CFP:
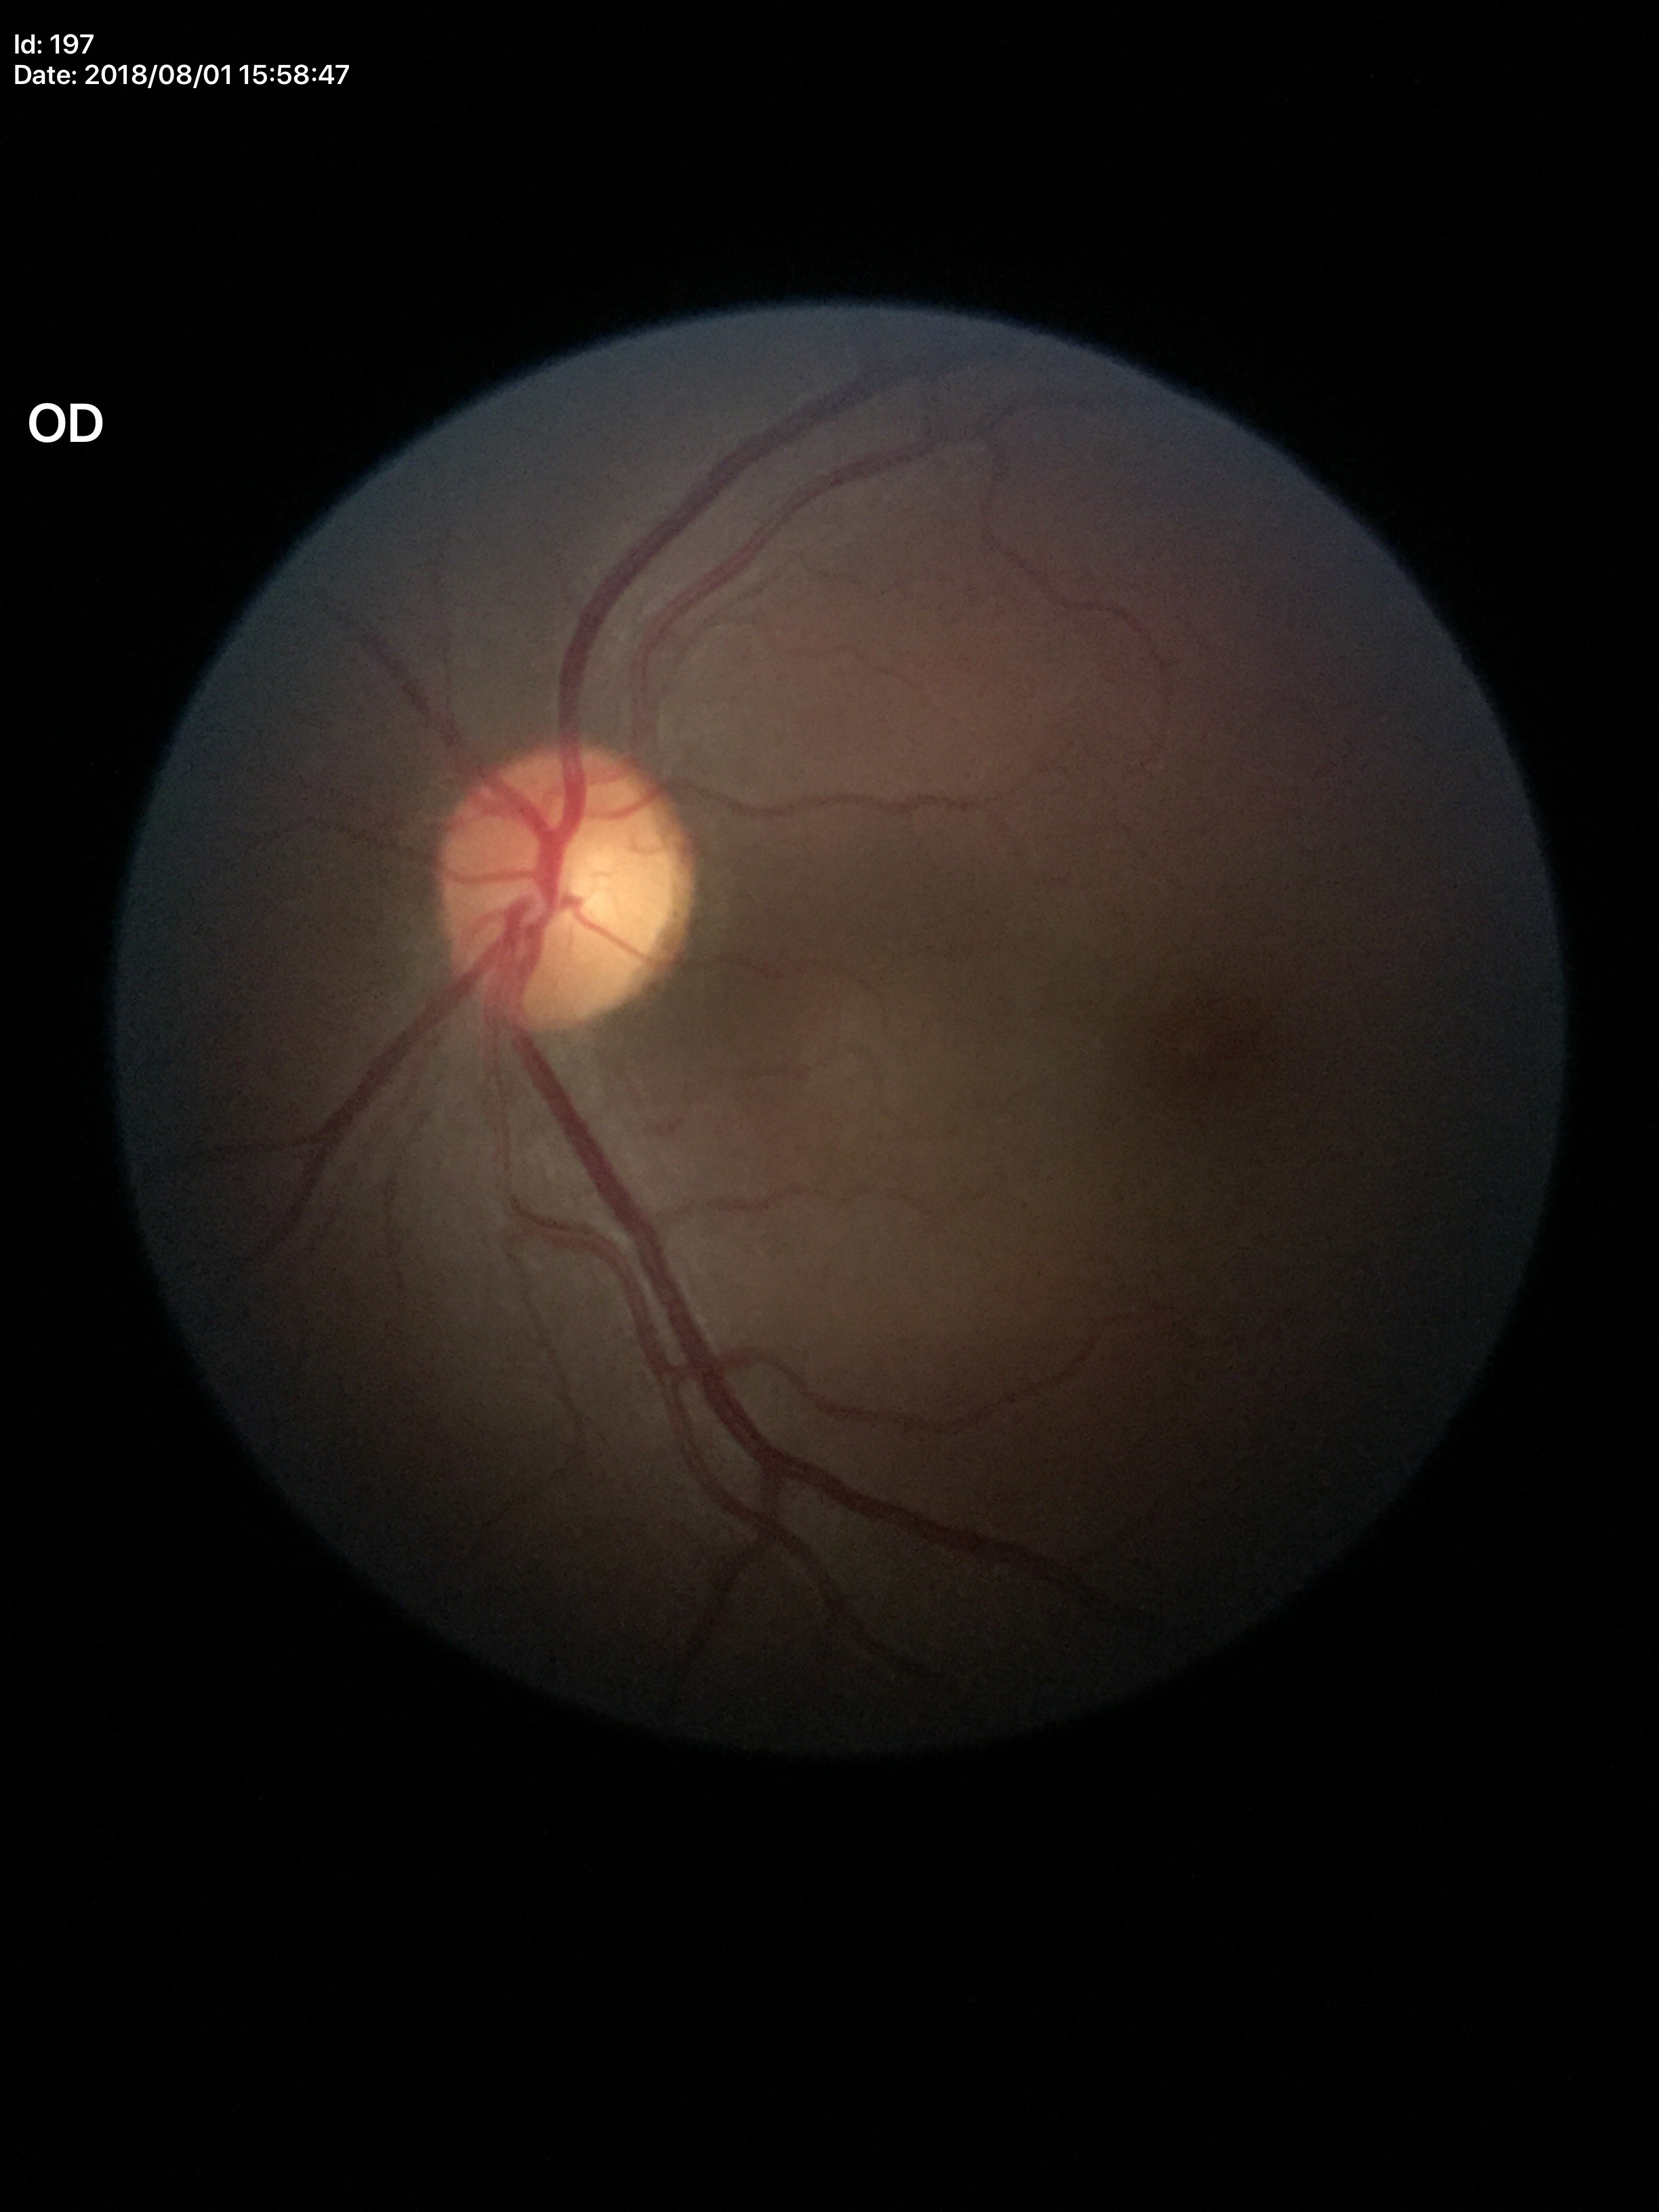
Glaucoma assessment: negative.
Vertical CDR: 0.49.